Image size 2184x1690.
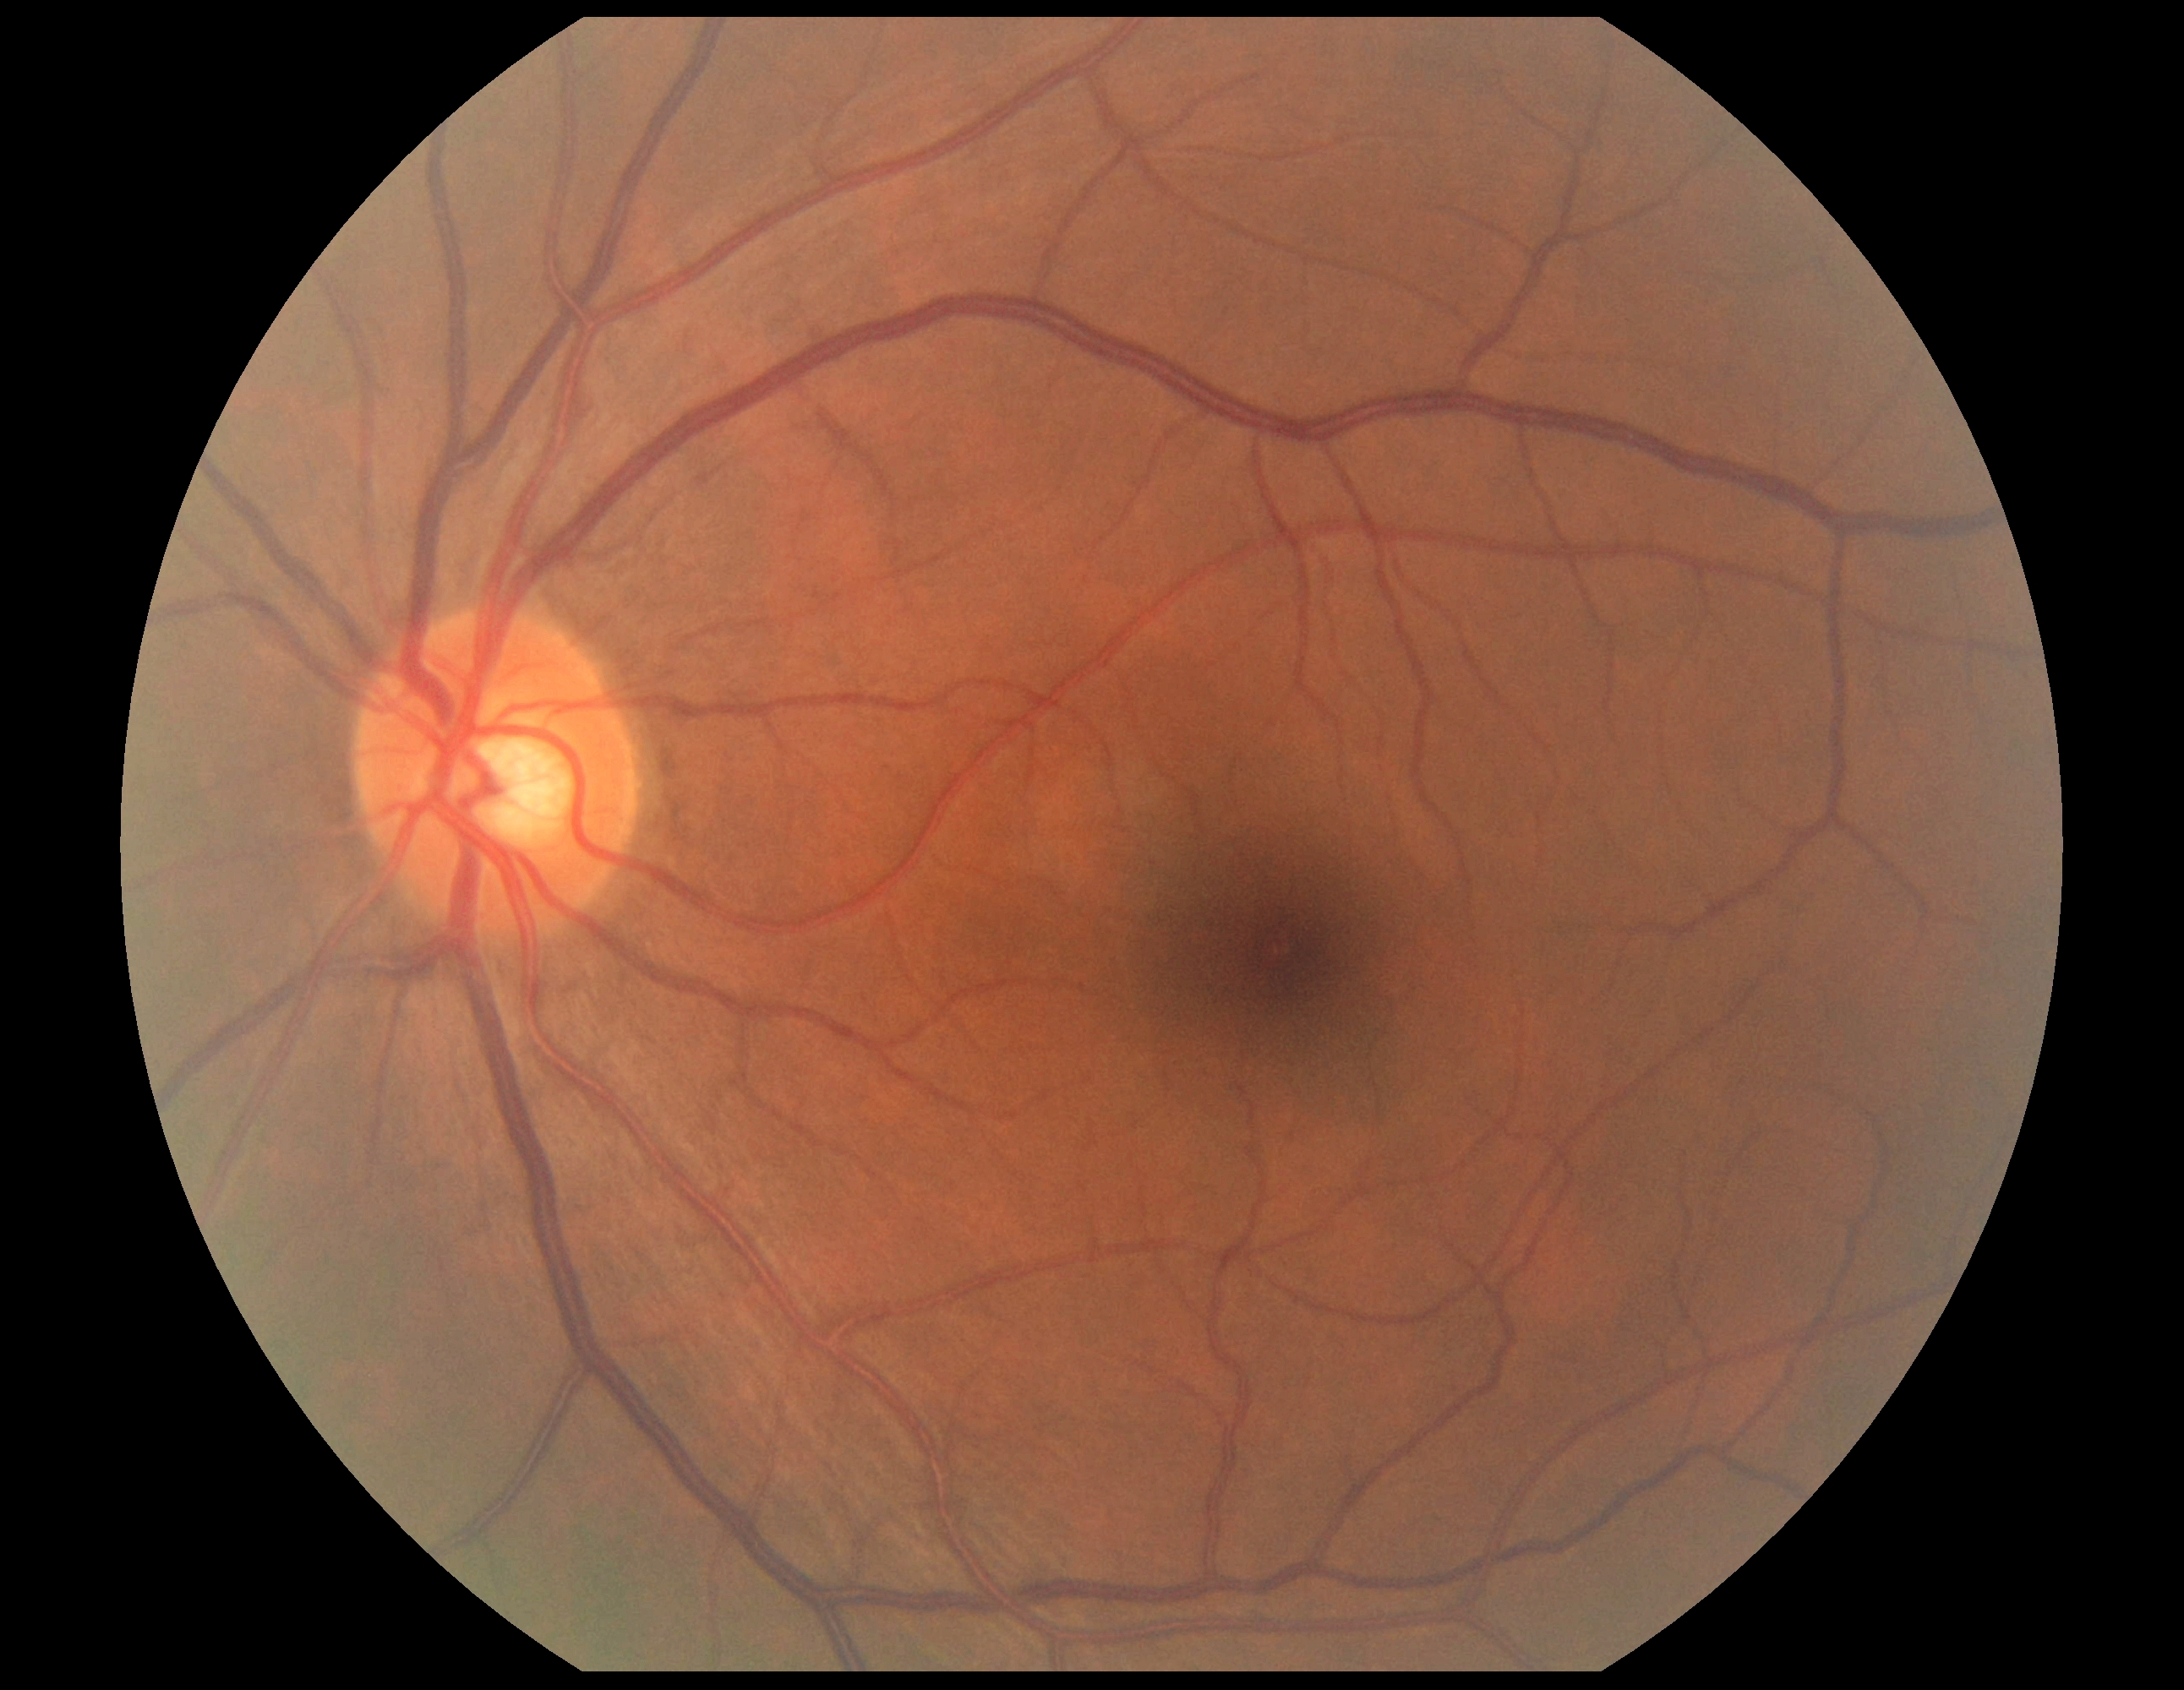 DR: grade 0 (no apparent retinopathy) — no visible signs of diabetic retinopathy. No DR findings.